848 x 848 pixels; acquired with a NIDEK AFC-230:
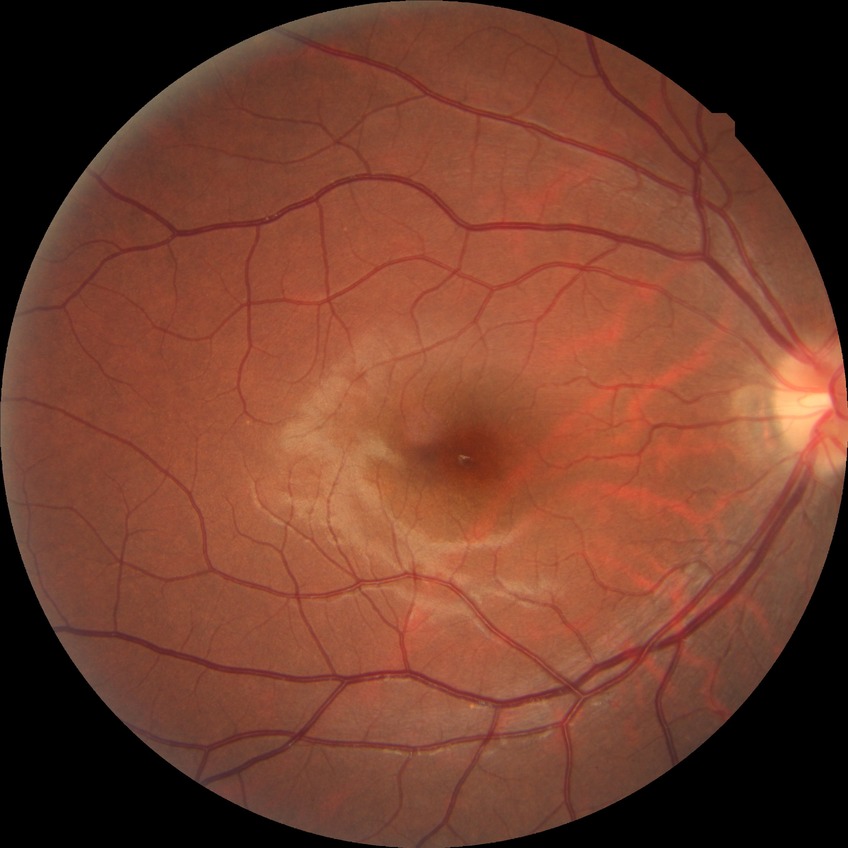 Diabetic retinopathy (DR) is no diabetic retinopathy (NDR).